45-degree field of view: 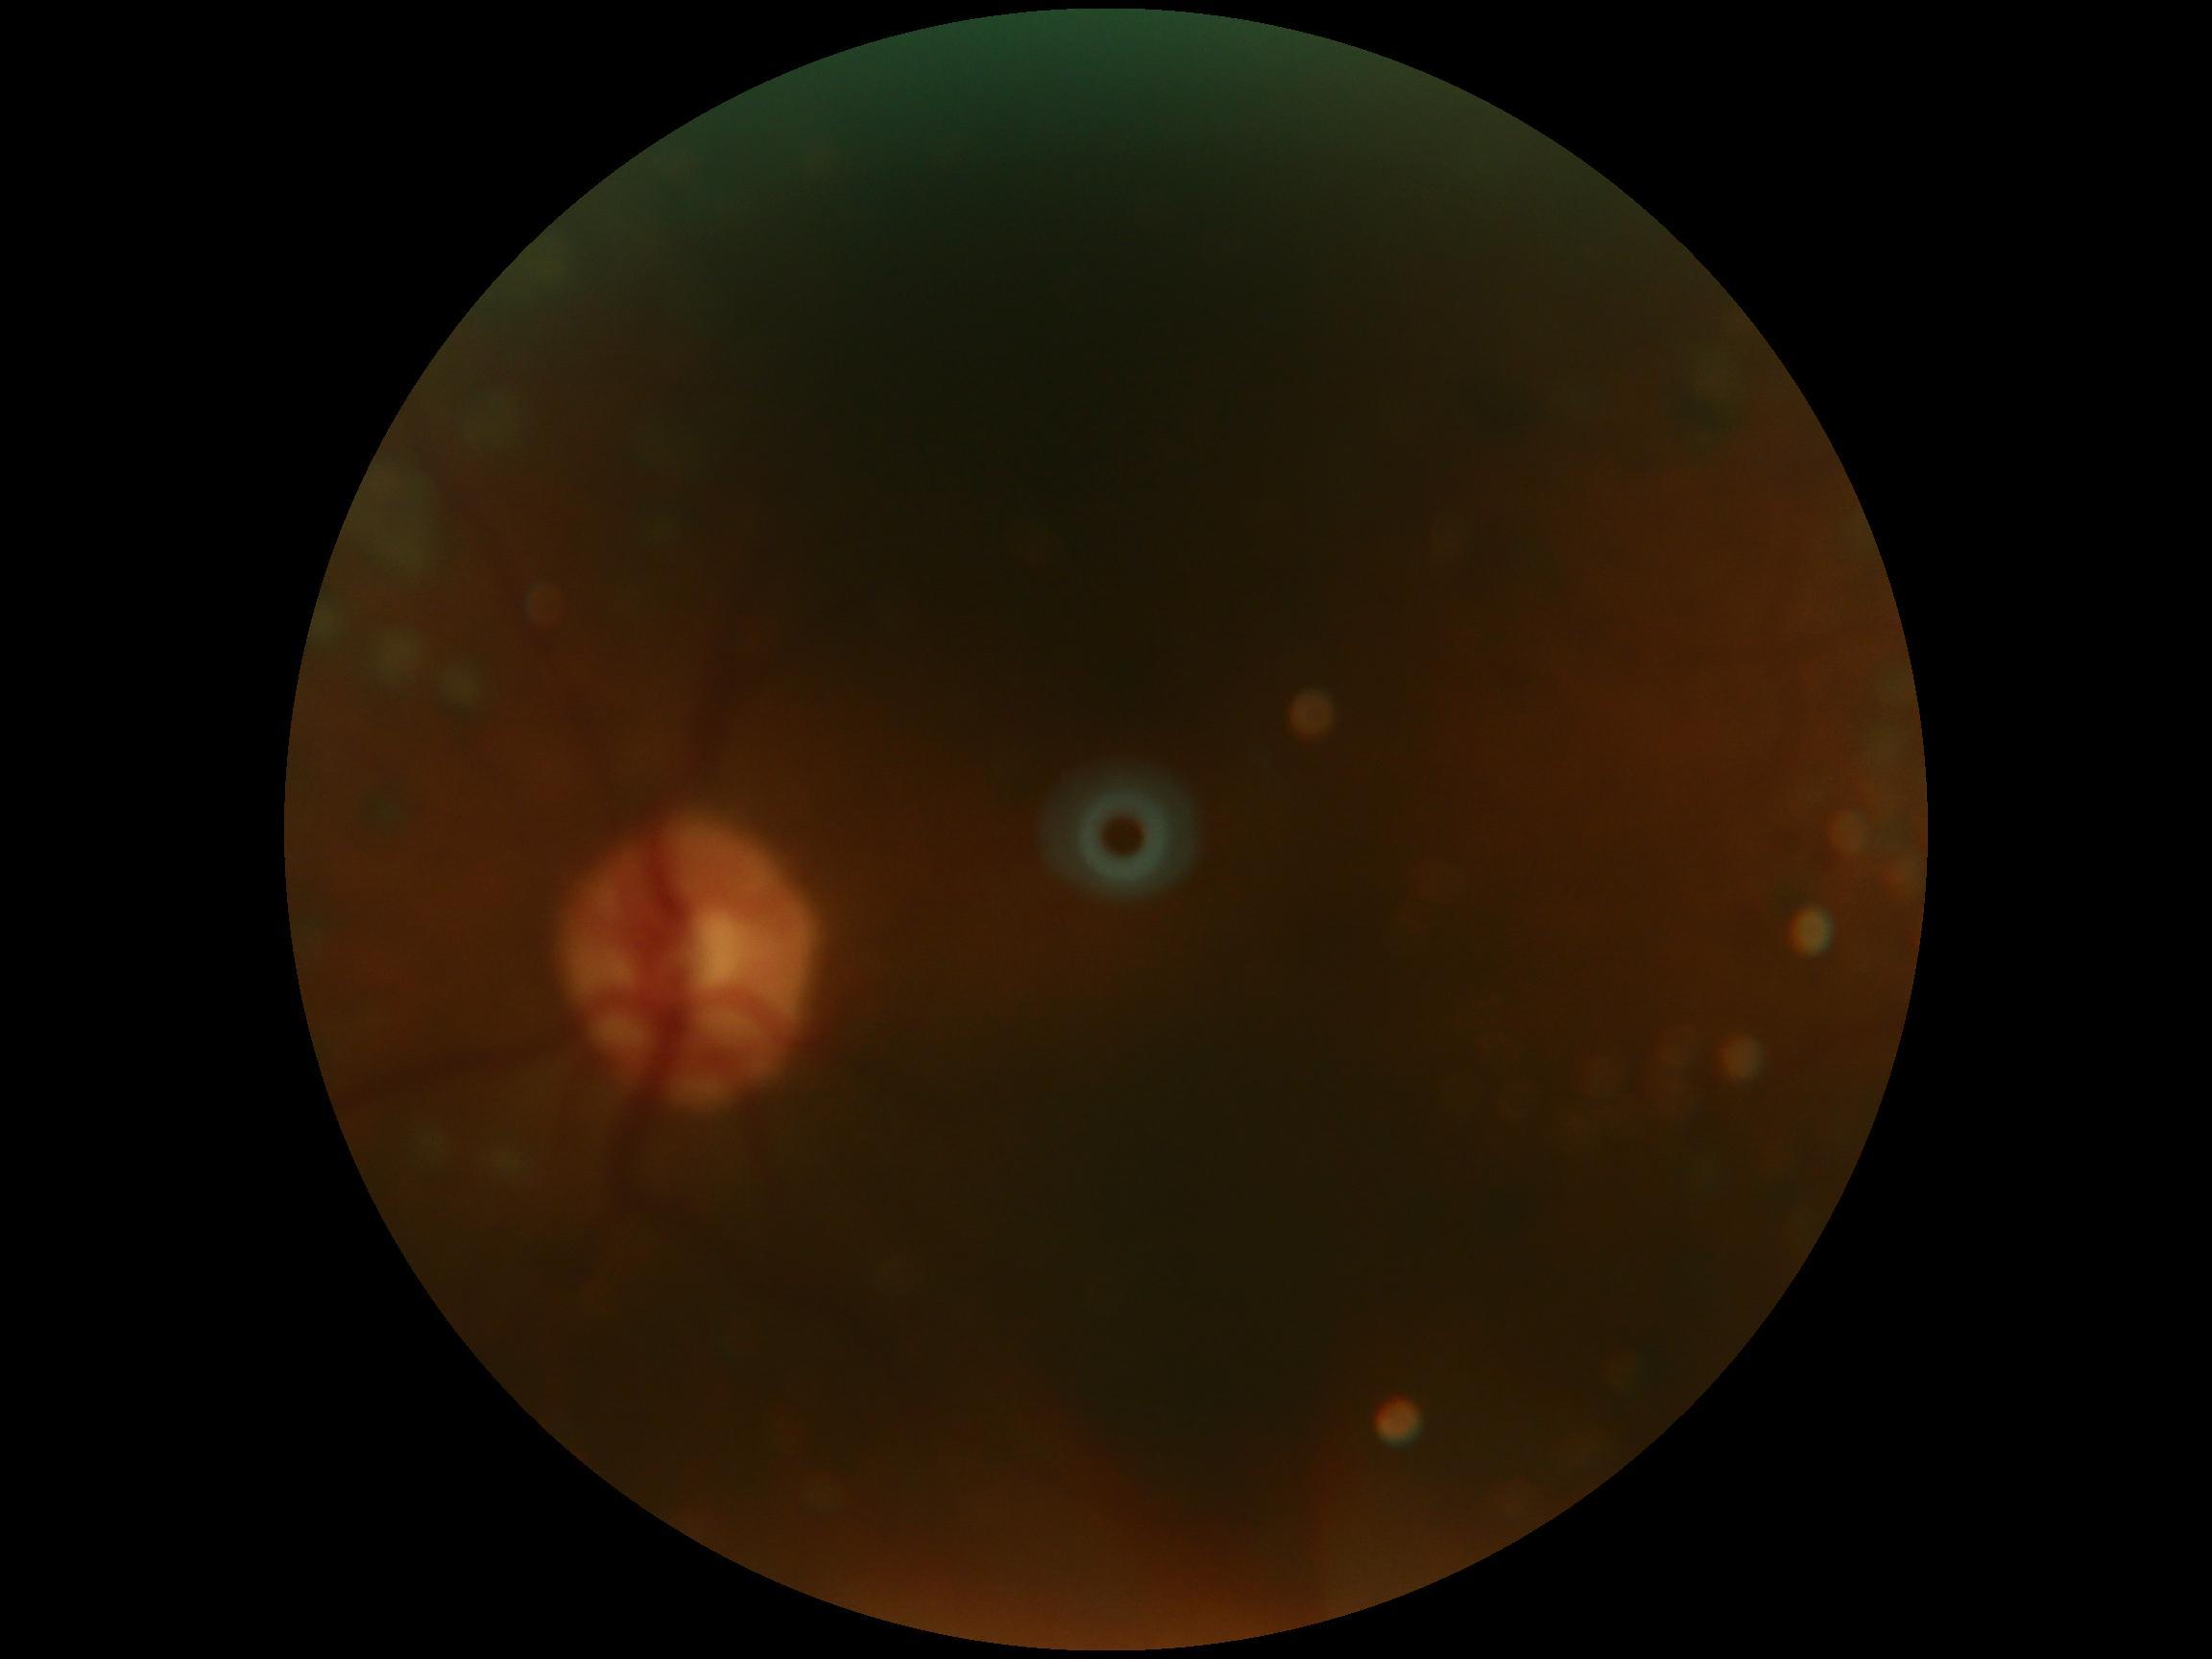 The image cannot be graded for diabetic retinopathy. Retinopathy grade is ungradable due to poor image quality.